Infant wide-field fundus photograph. 100° field of view (Phoenix ICON).
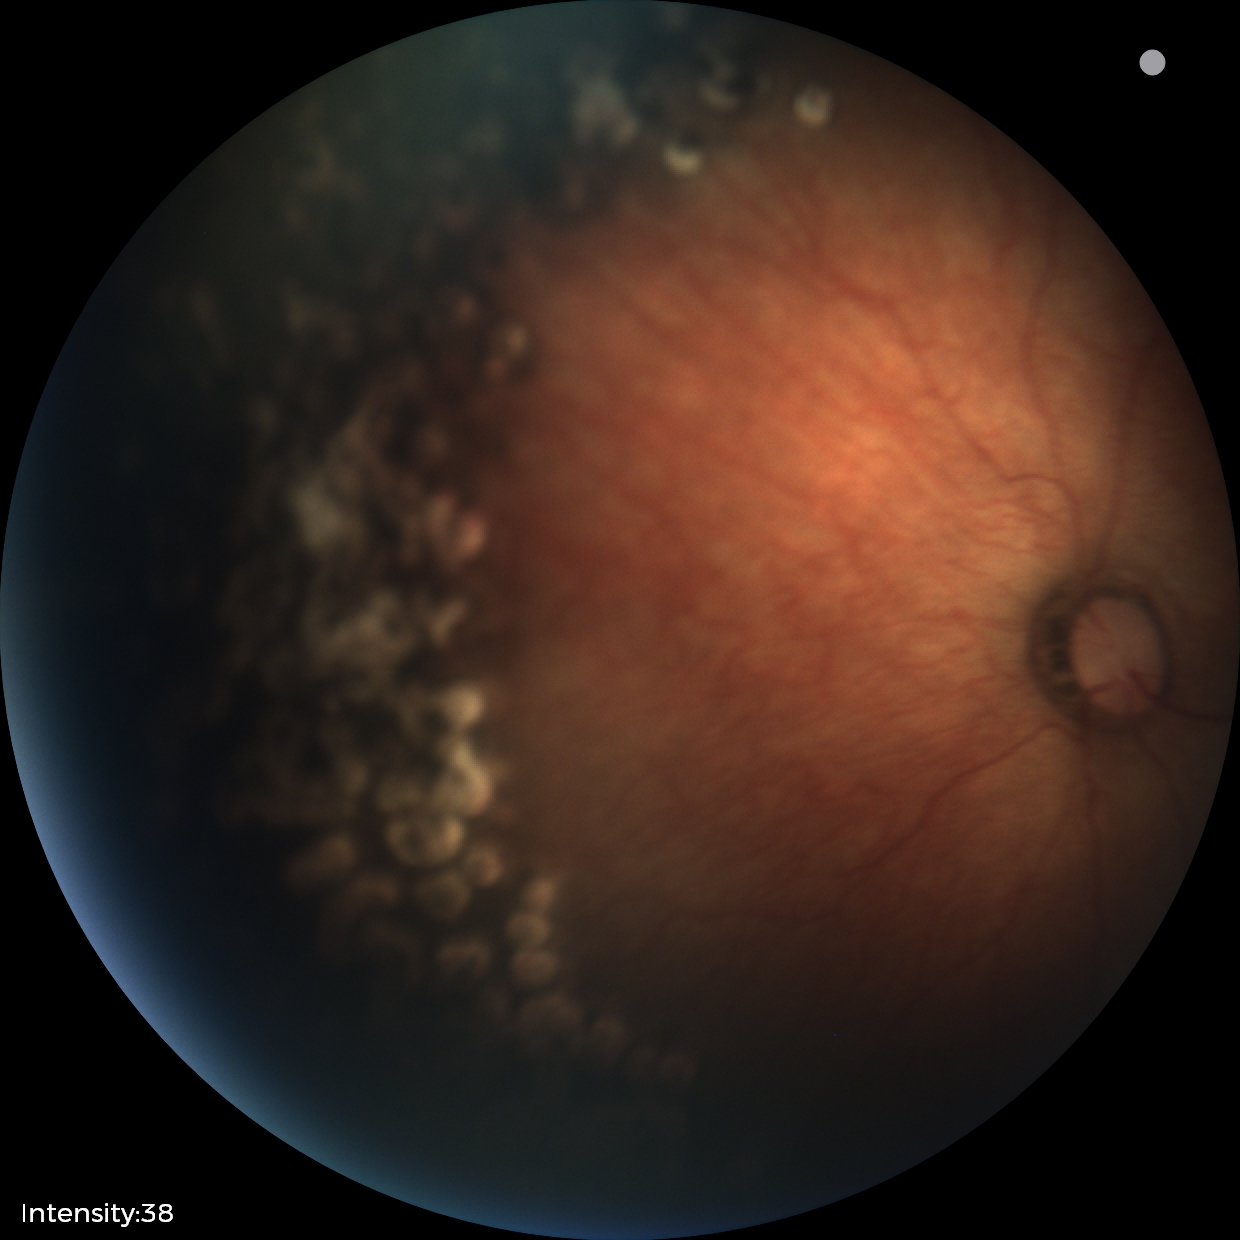
Examination diagnosed as status post ROP.